45-degree field of view. CFP. Without pupil dilation.
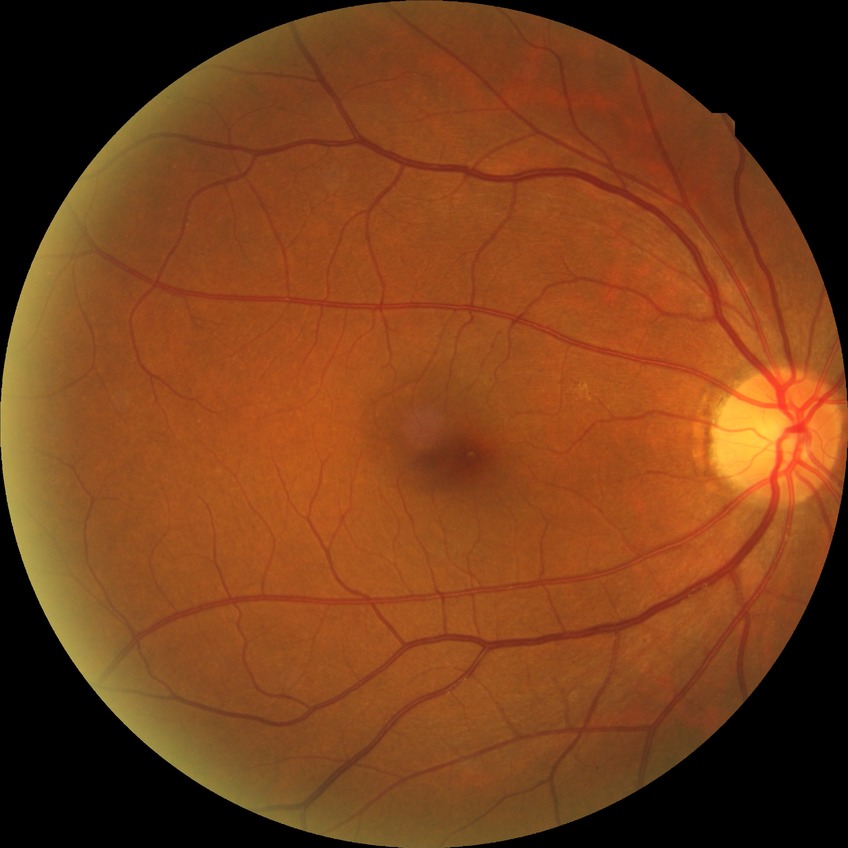

Davis DR grade: SDR.